45-degree field of view · 2352x1568px — 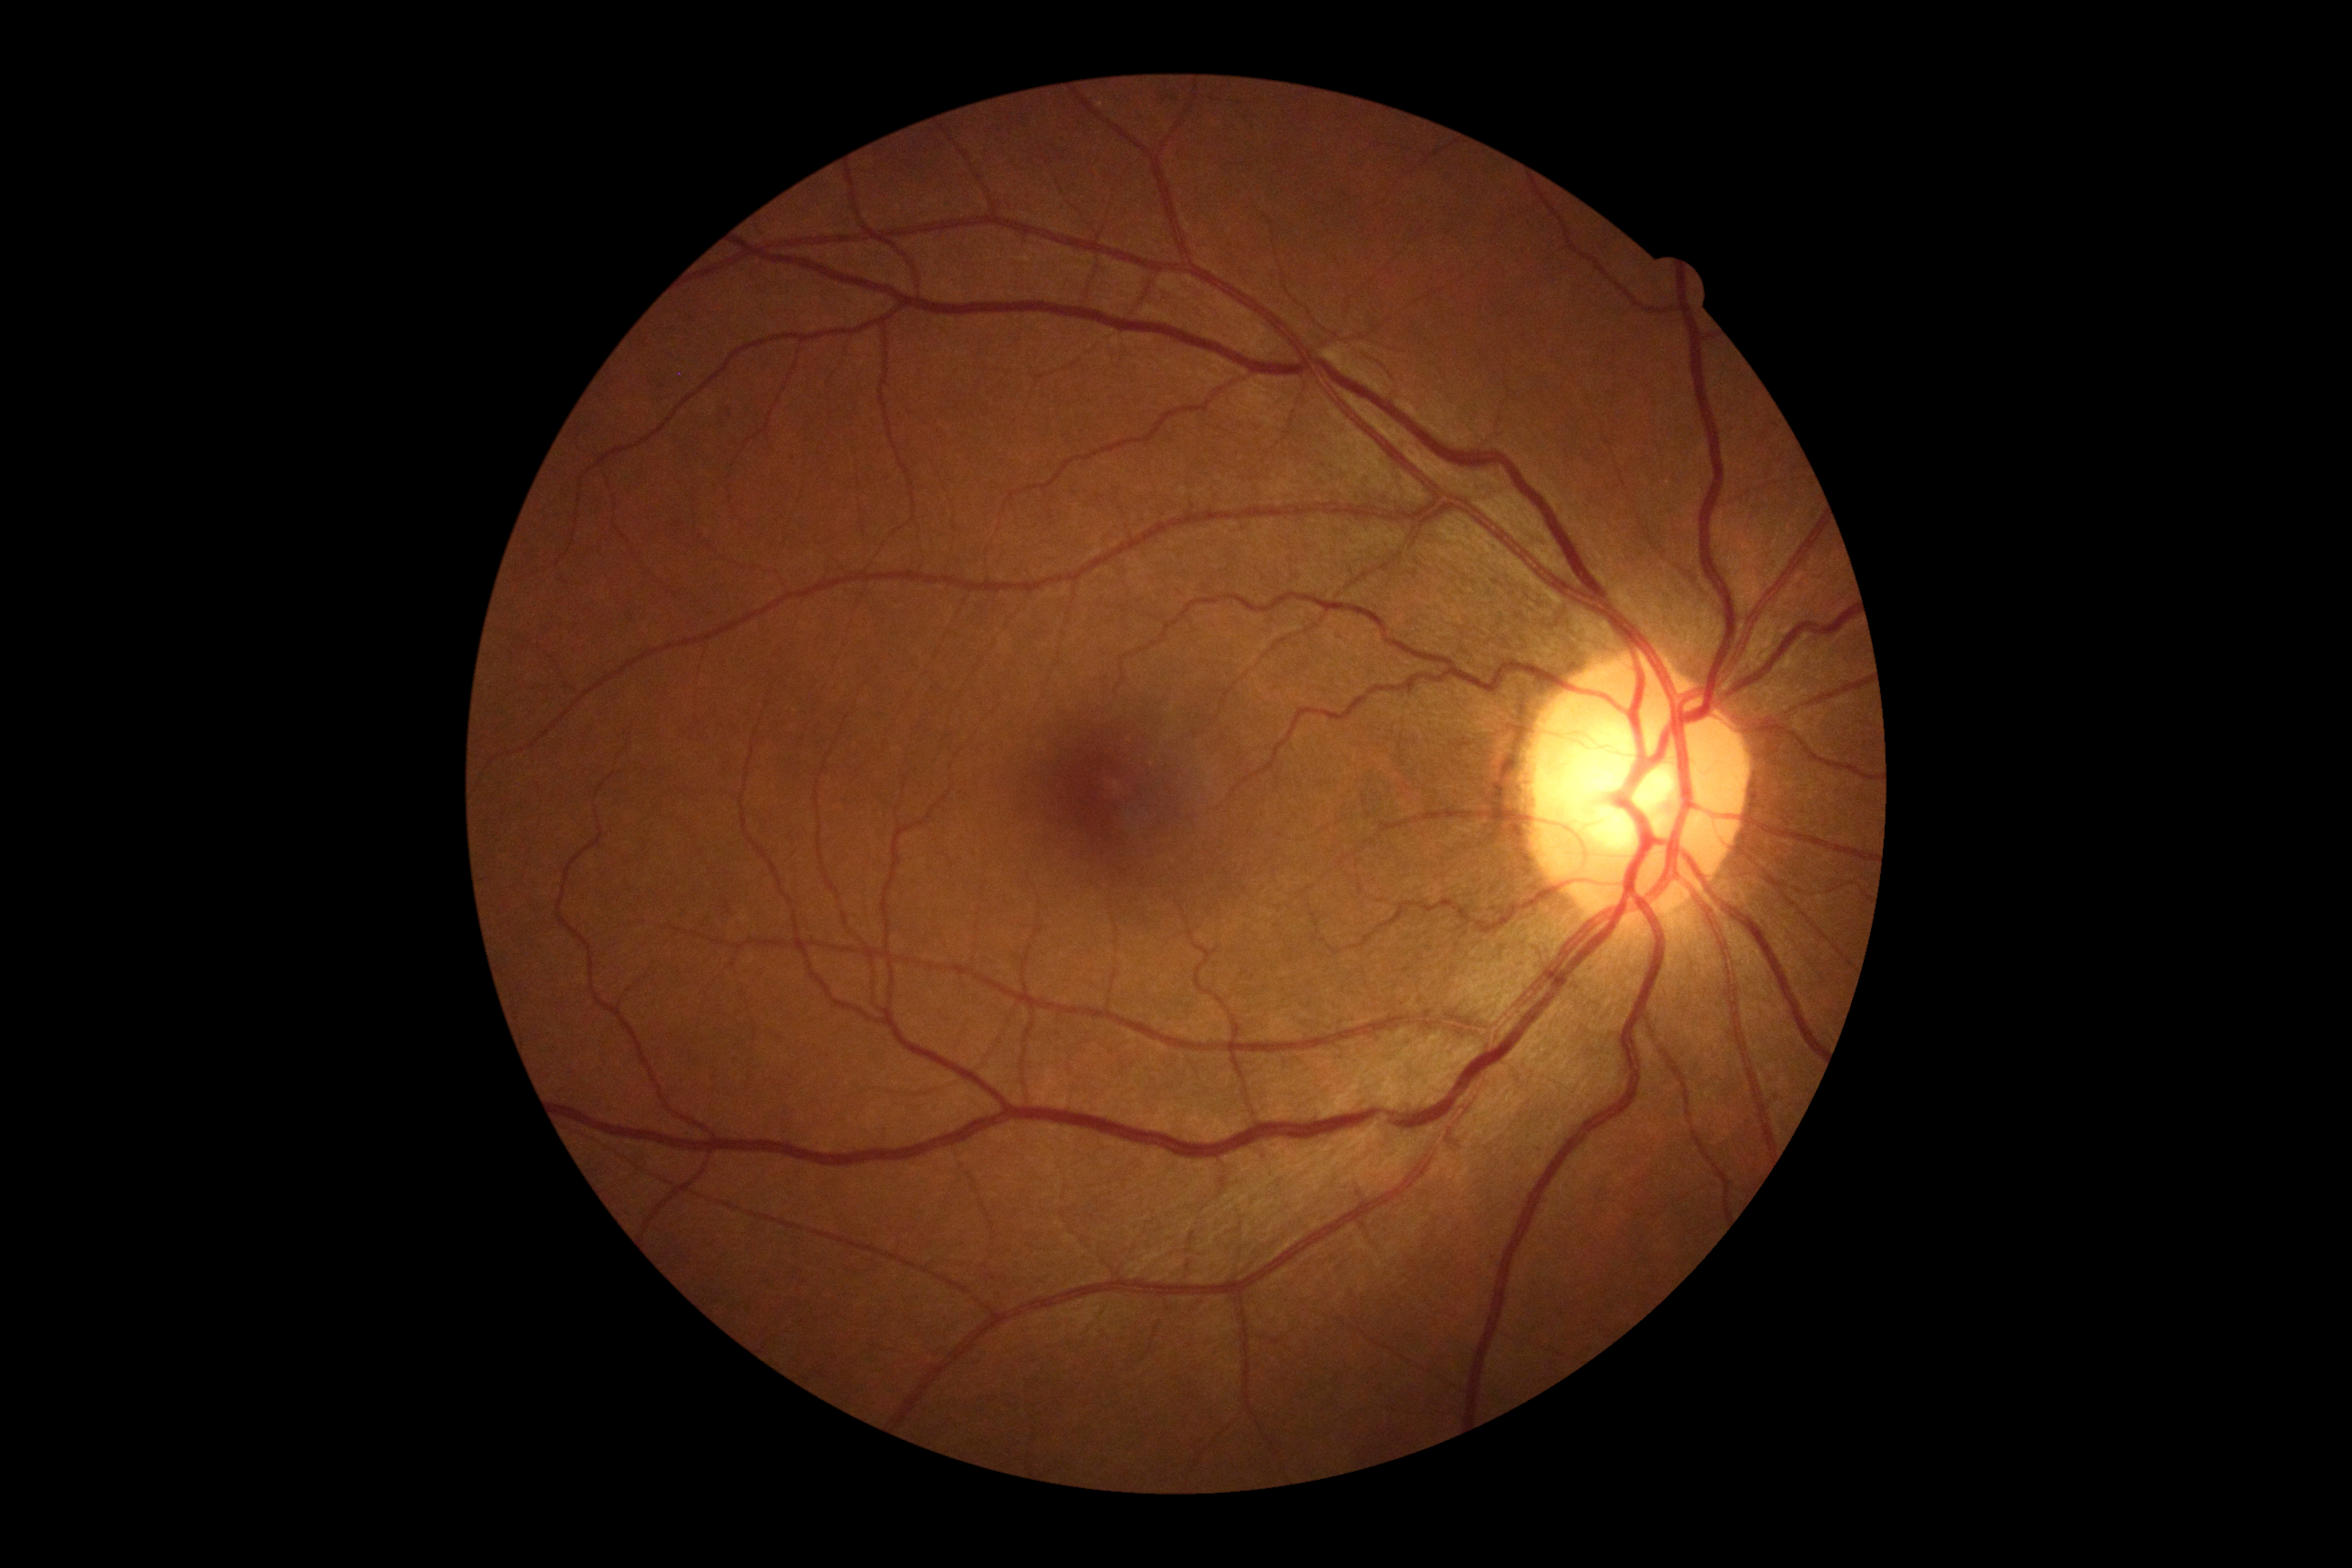 No apparent diabetic retinopathy.
DR grade: 0 (no apparent retinopathy).